2228 x 1652 pixels · fundus photo.
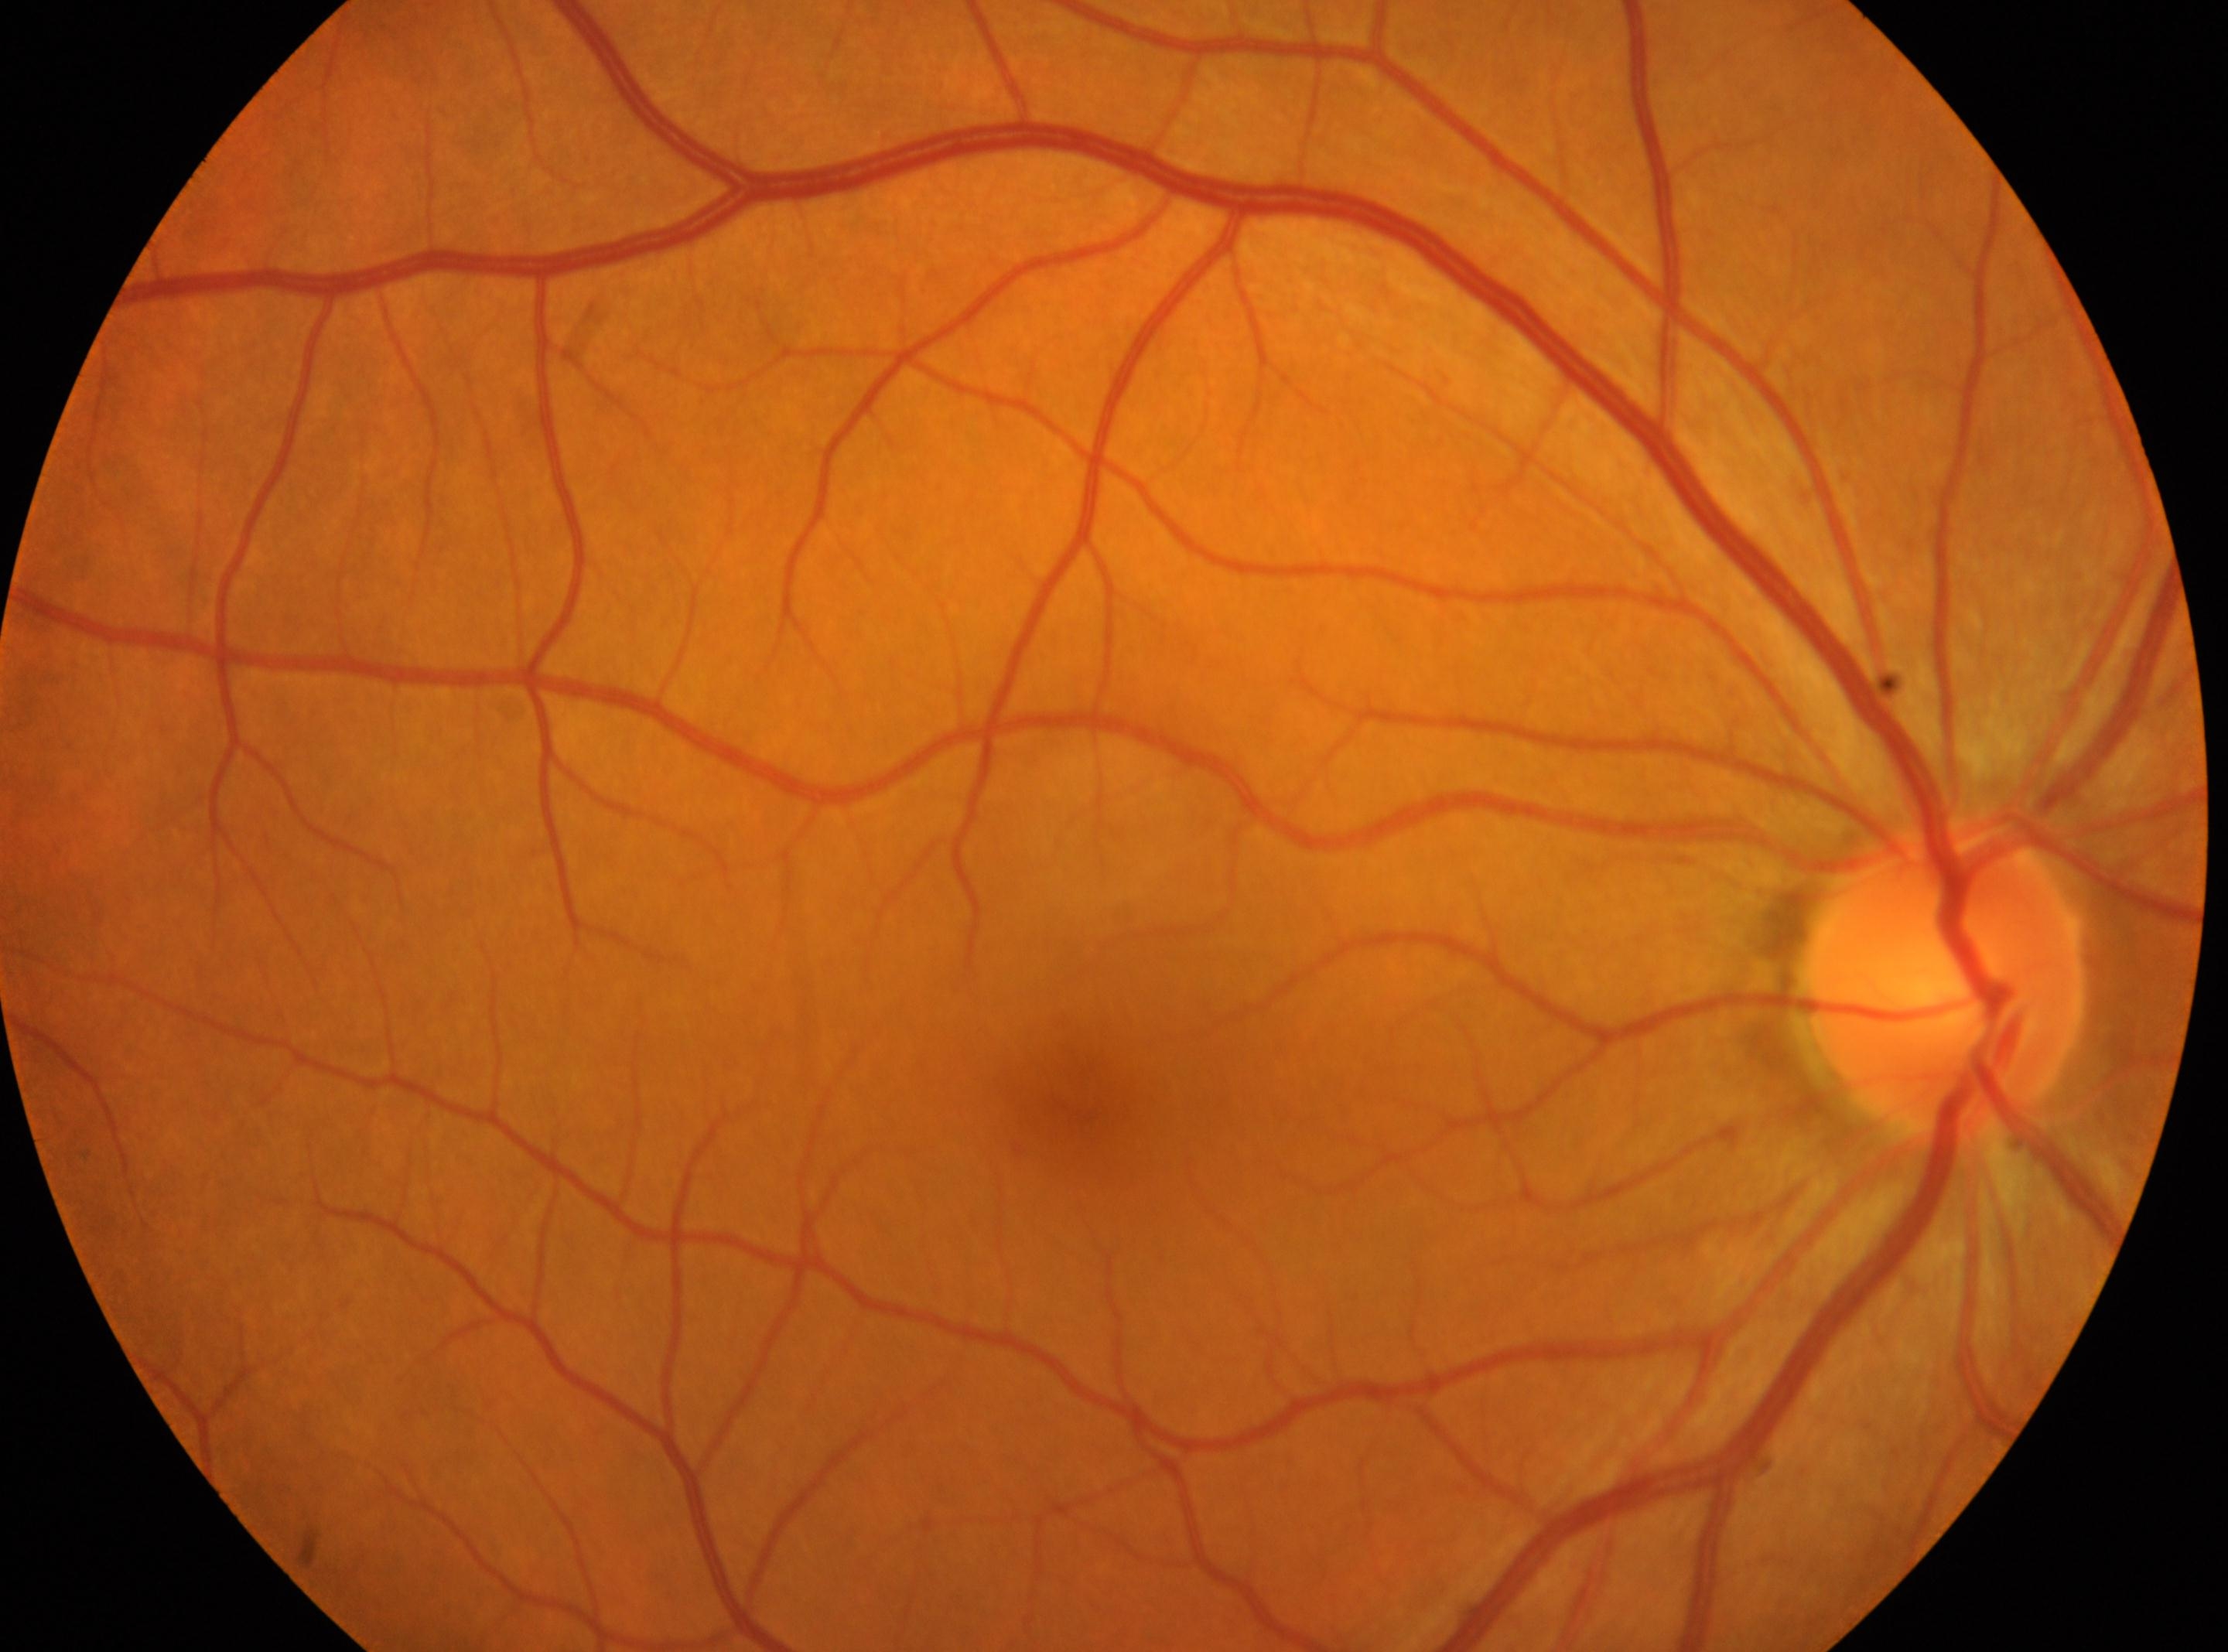
| feature | annotation |
|---|---|
| disc center | (x=1946, y=976) |
| diabetic retinopathy (DR) | no apparent diabetic retinopathy (grade 0) — no visible signs of diabetic retinopathy |
| fovea centralis | (x=1085, y=1106) |
| laterality | right eye |